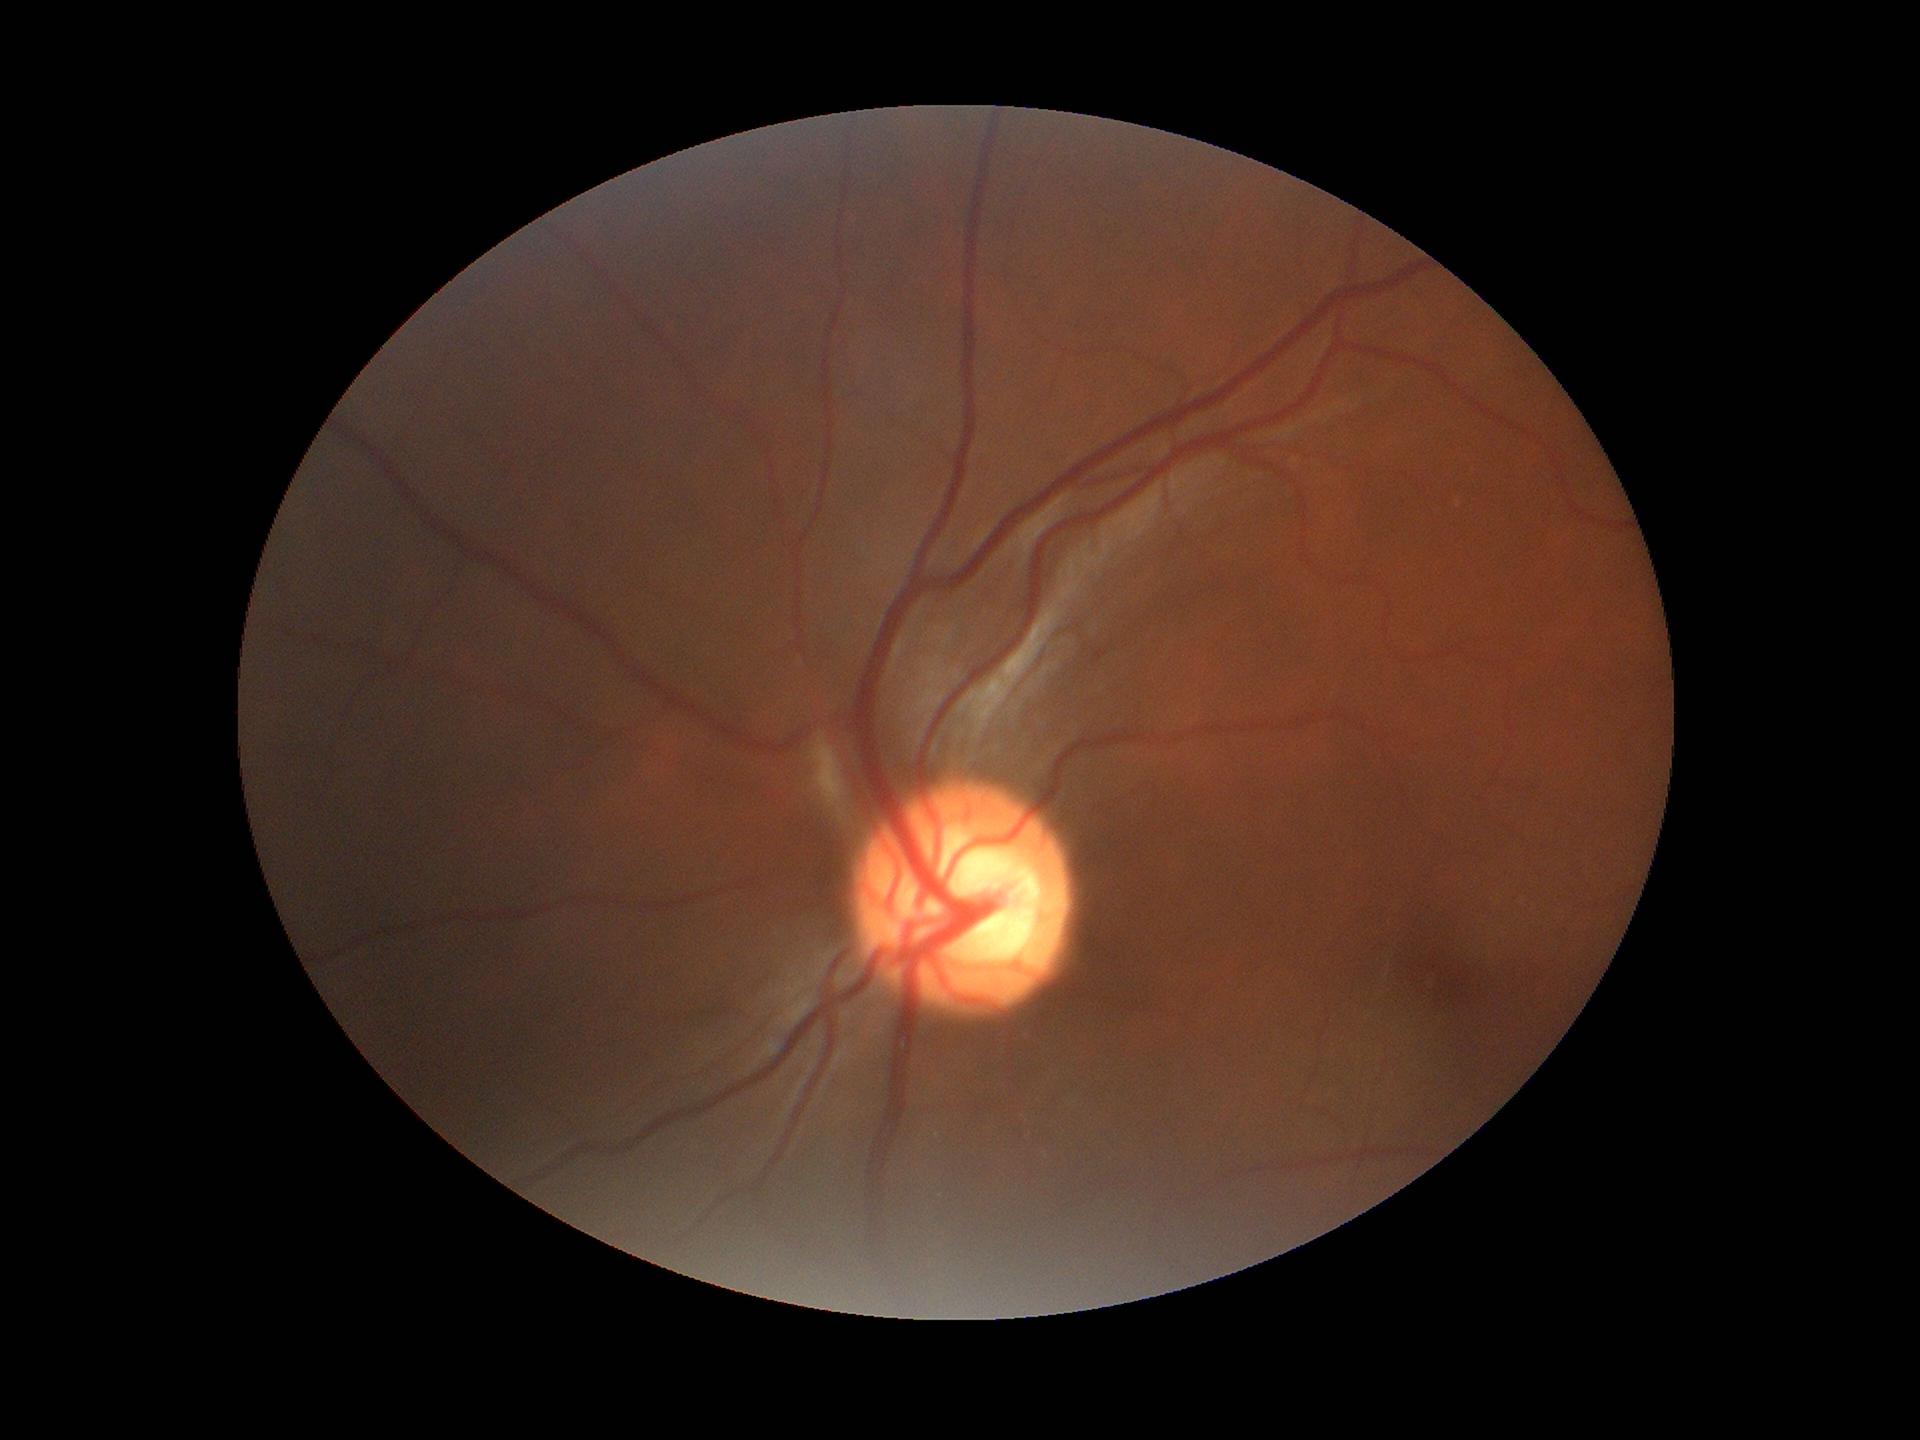

Glaucoma evaluation: suspicious findings.
VCDR: 0.64.